Man. 30° FOV. Captured on a Topcon TRC-NW400 fundus camera. Refraction: +3.25 -1.25 × 100°. Captured without pupil dilation — 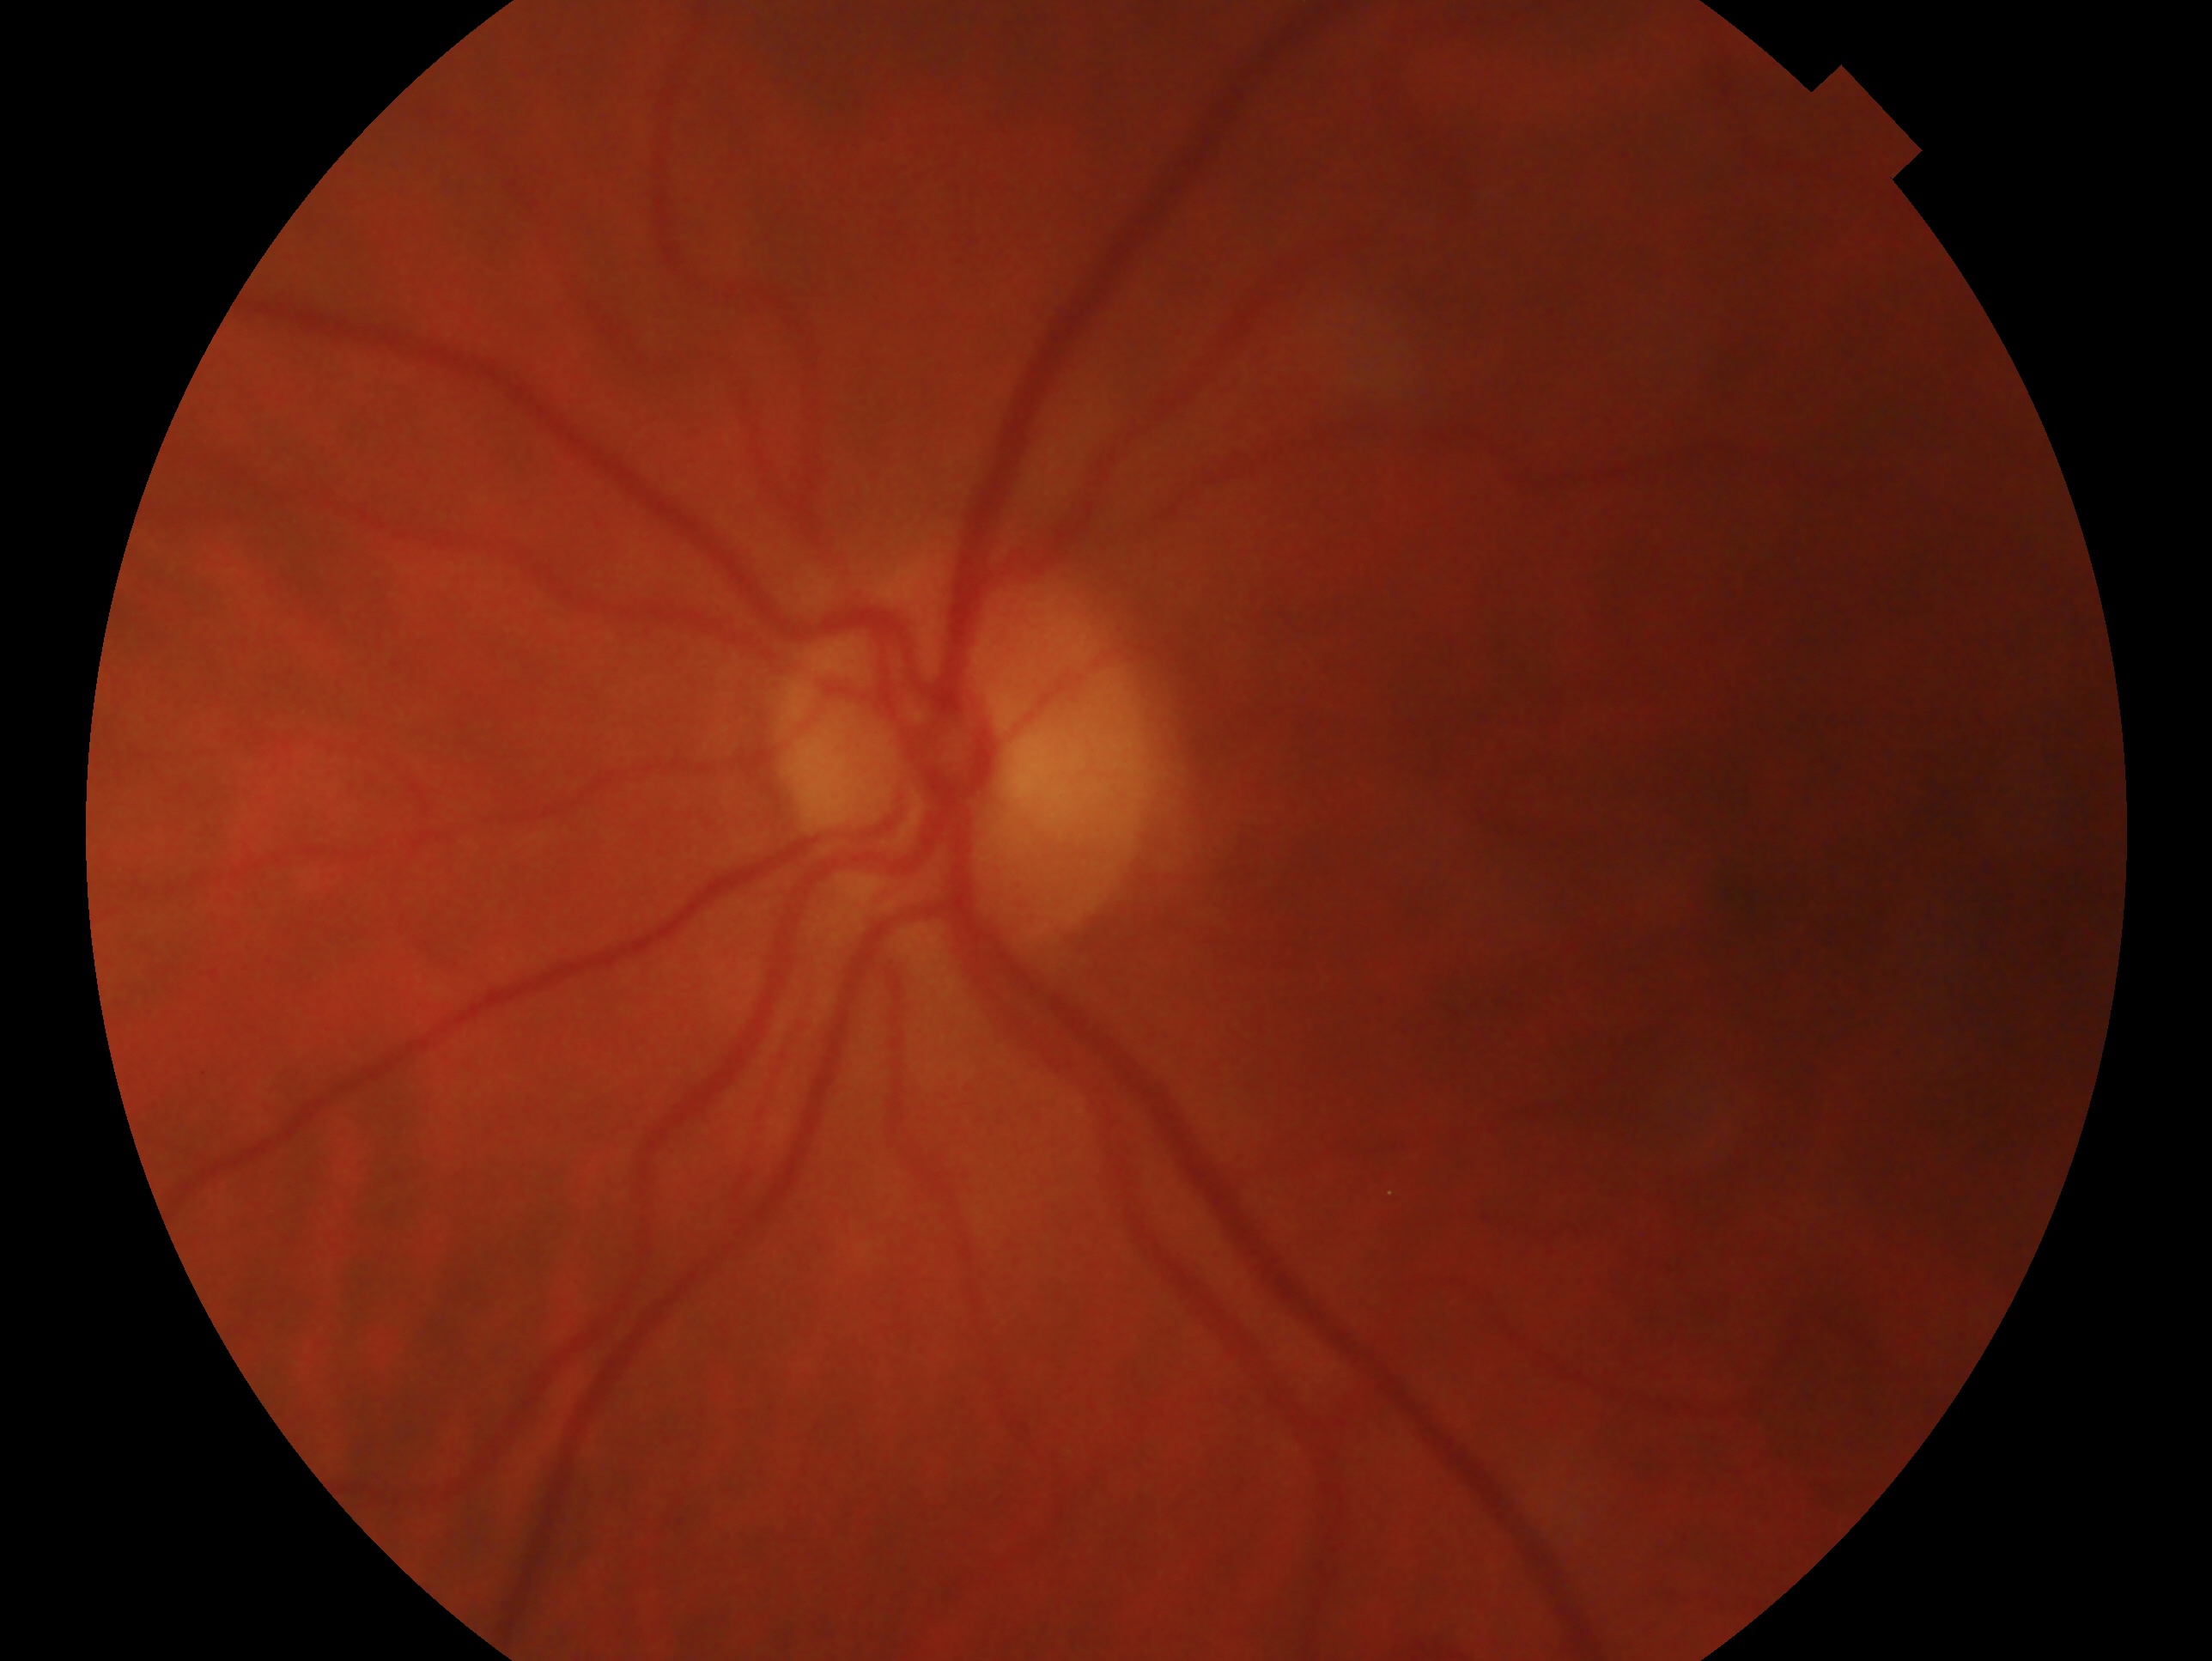
  glaucoma_dx: no signs of glaucoma
  eye: left